Wide-field fundus photograph from neonatal ROP screening; 1240 by 1240 pixels.
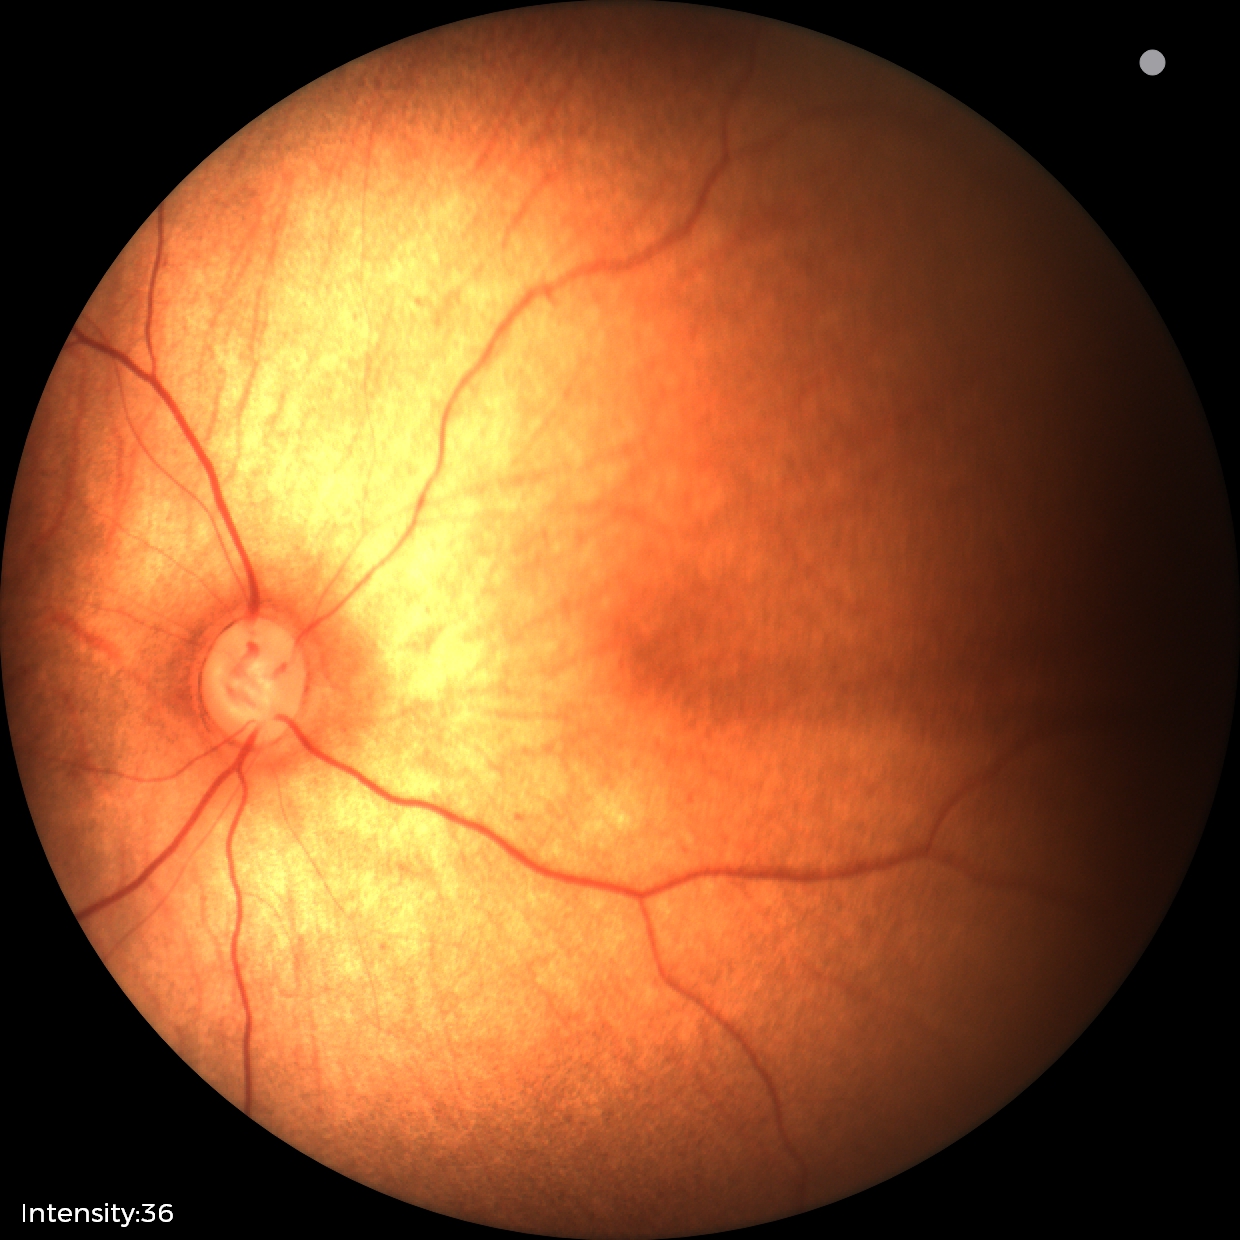
Screening examination diagnosed as physiological.